Camera: Clarity RetCam 3 (130° FOV) · infant wide-field fundus photograph
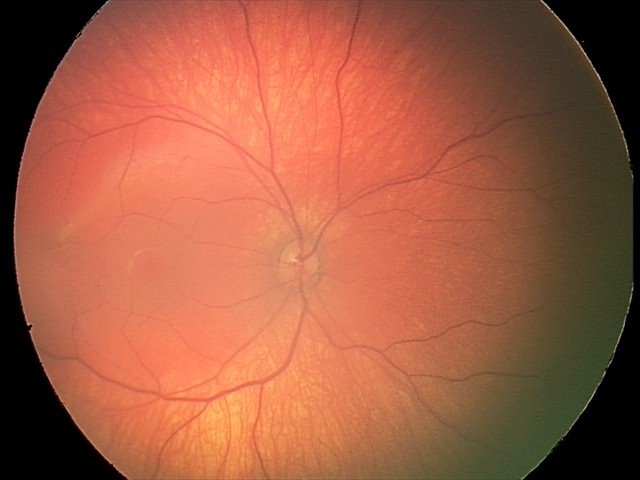 Normal screening examination.